45° FOV
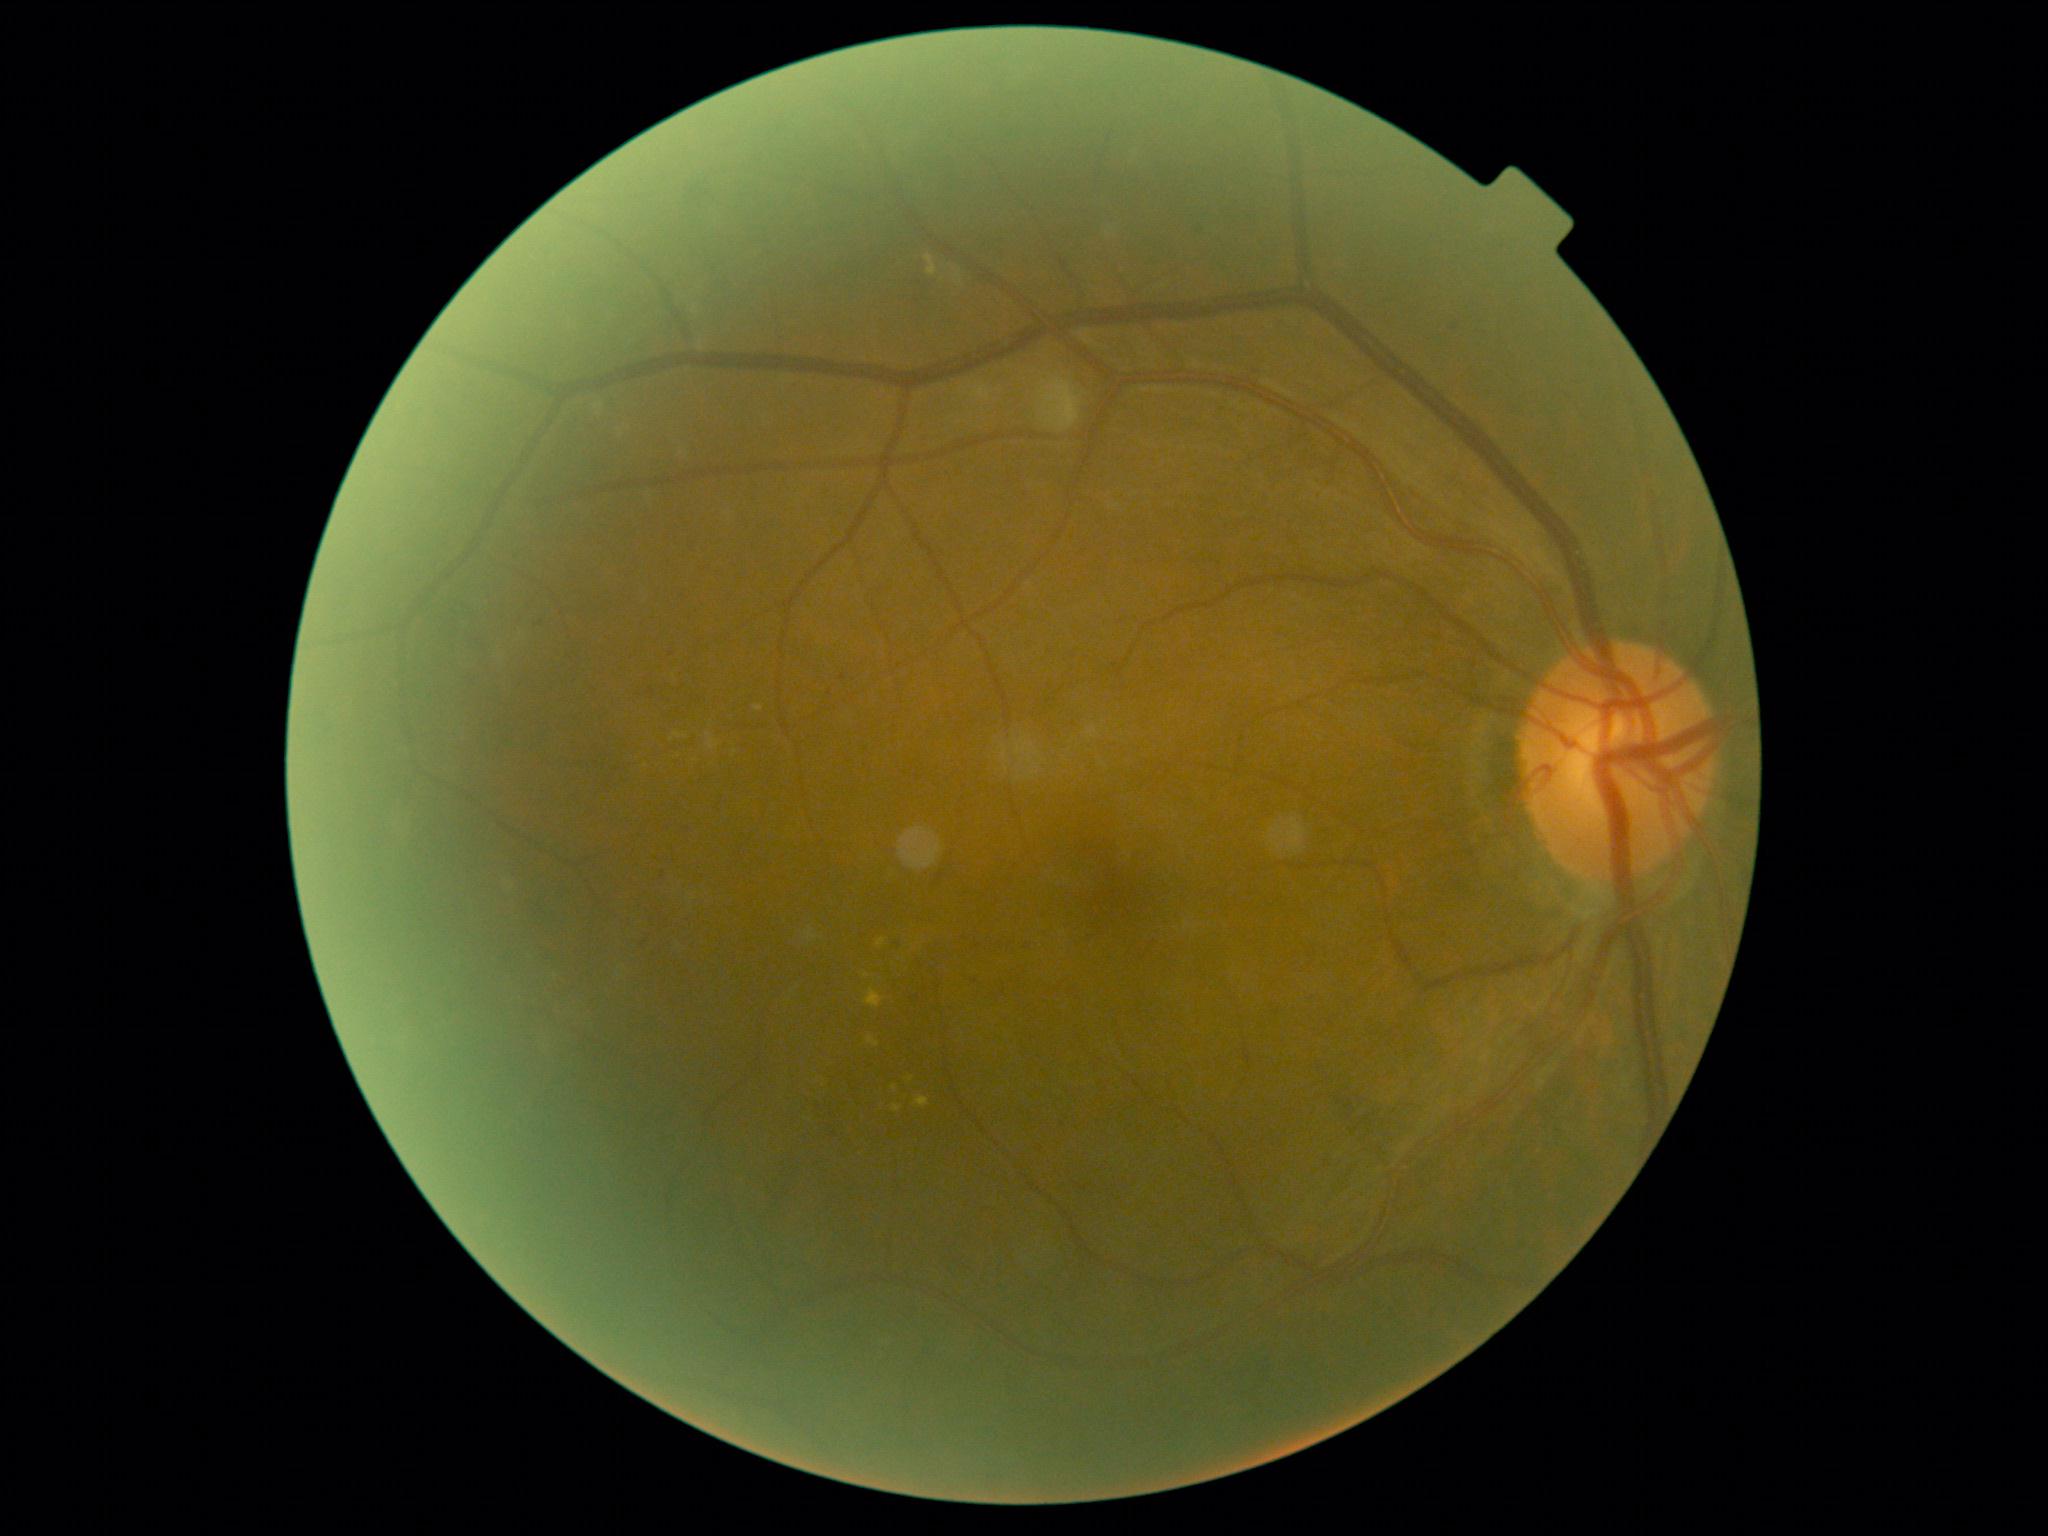
Diabetic retinopathy (DR) is 2/4.